45-degree field of view · retinal fundus photograph · 2352 by 1568 pixels: 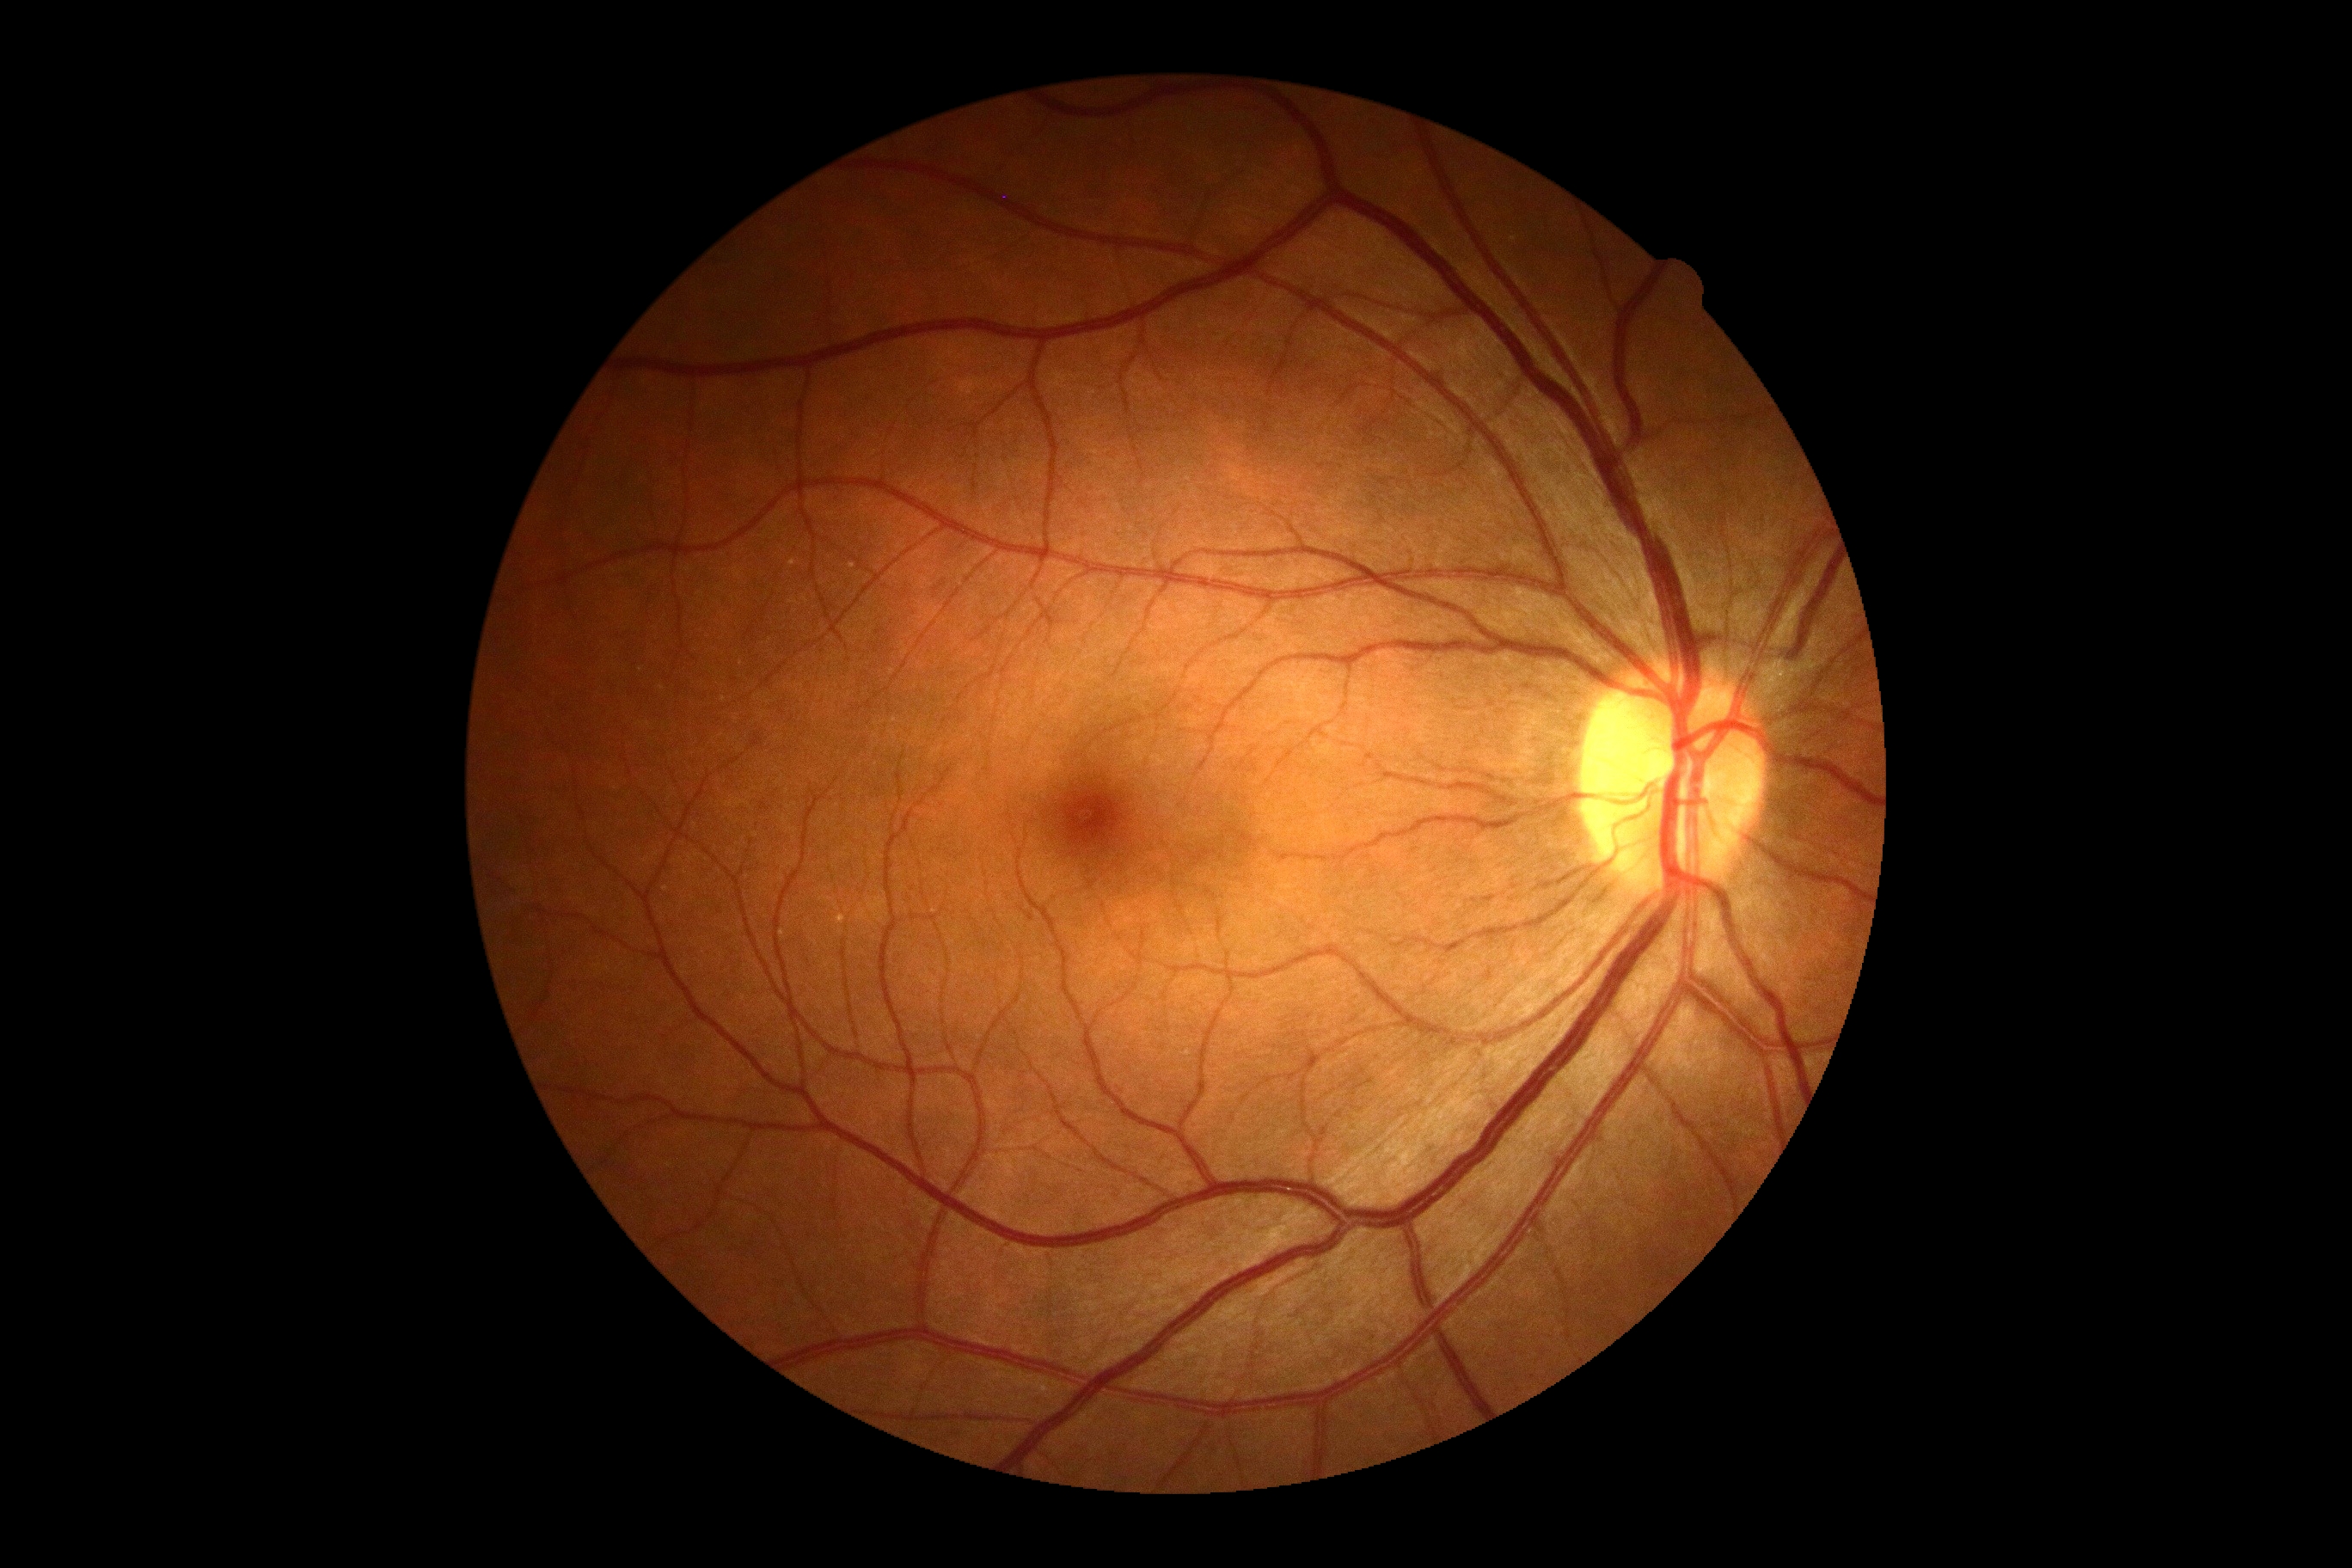 Findings:
– DR severity — grade 0 (no apparent retinopathy)